45° FOV · 412 x 310 pixels · CFP — 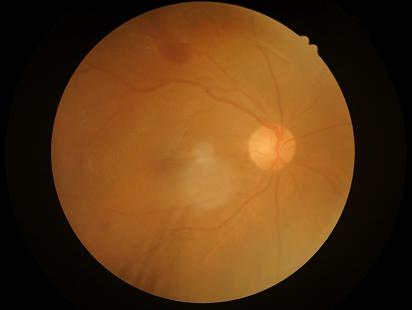

Quality assessment: sharpness: optic disc, vessels, and background in focus | contrast: low, vessels and details hard to distinguish | illumination/color: over- or under-exposed | overall: poor and difficult to use diagnostically.